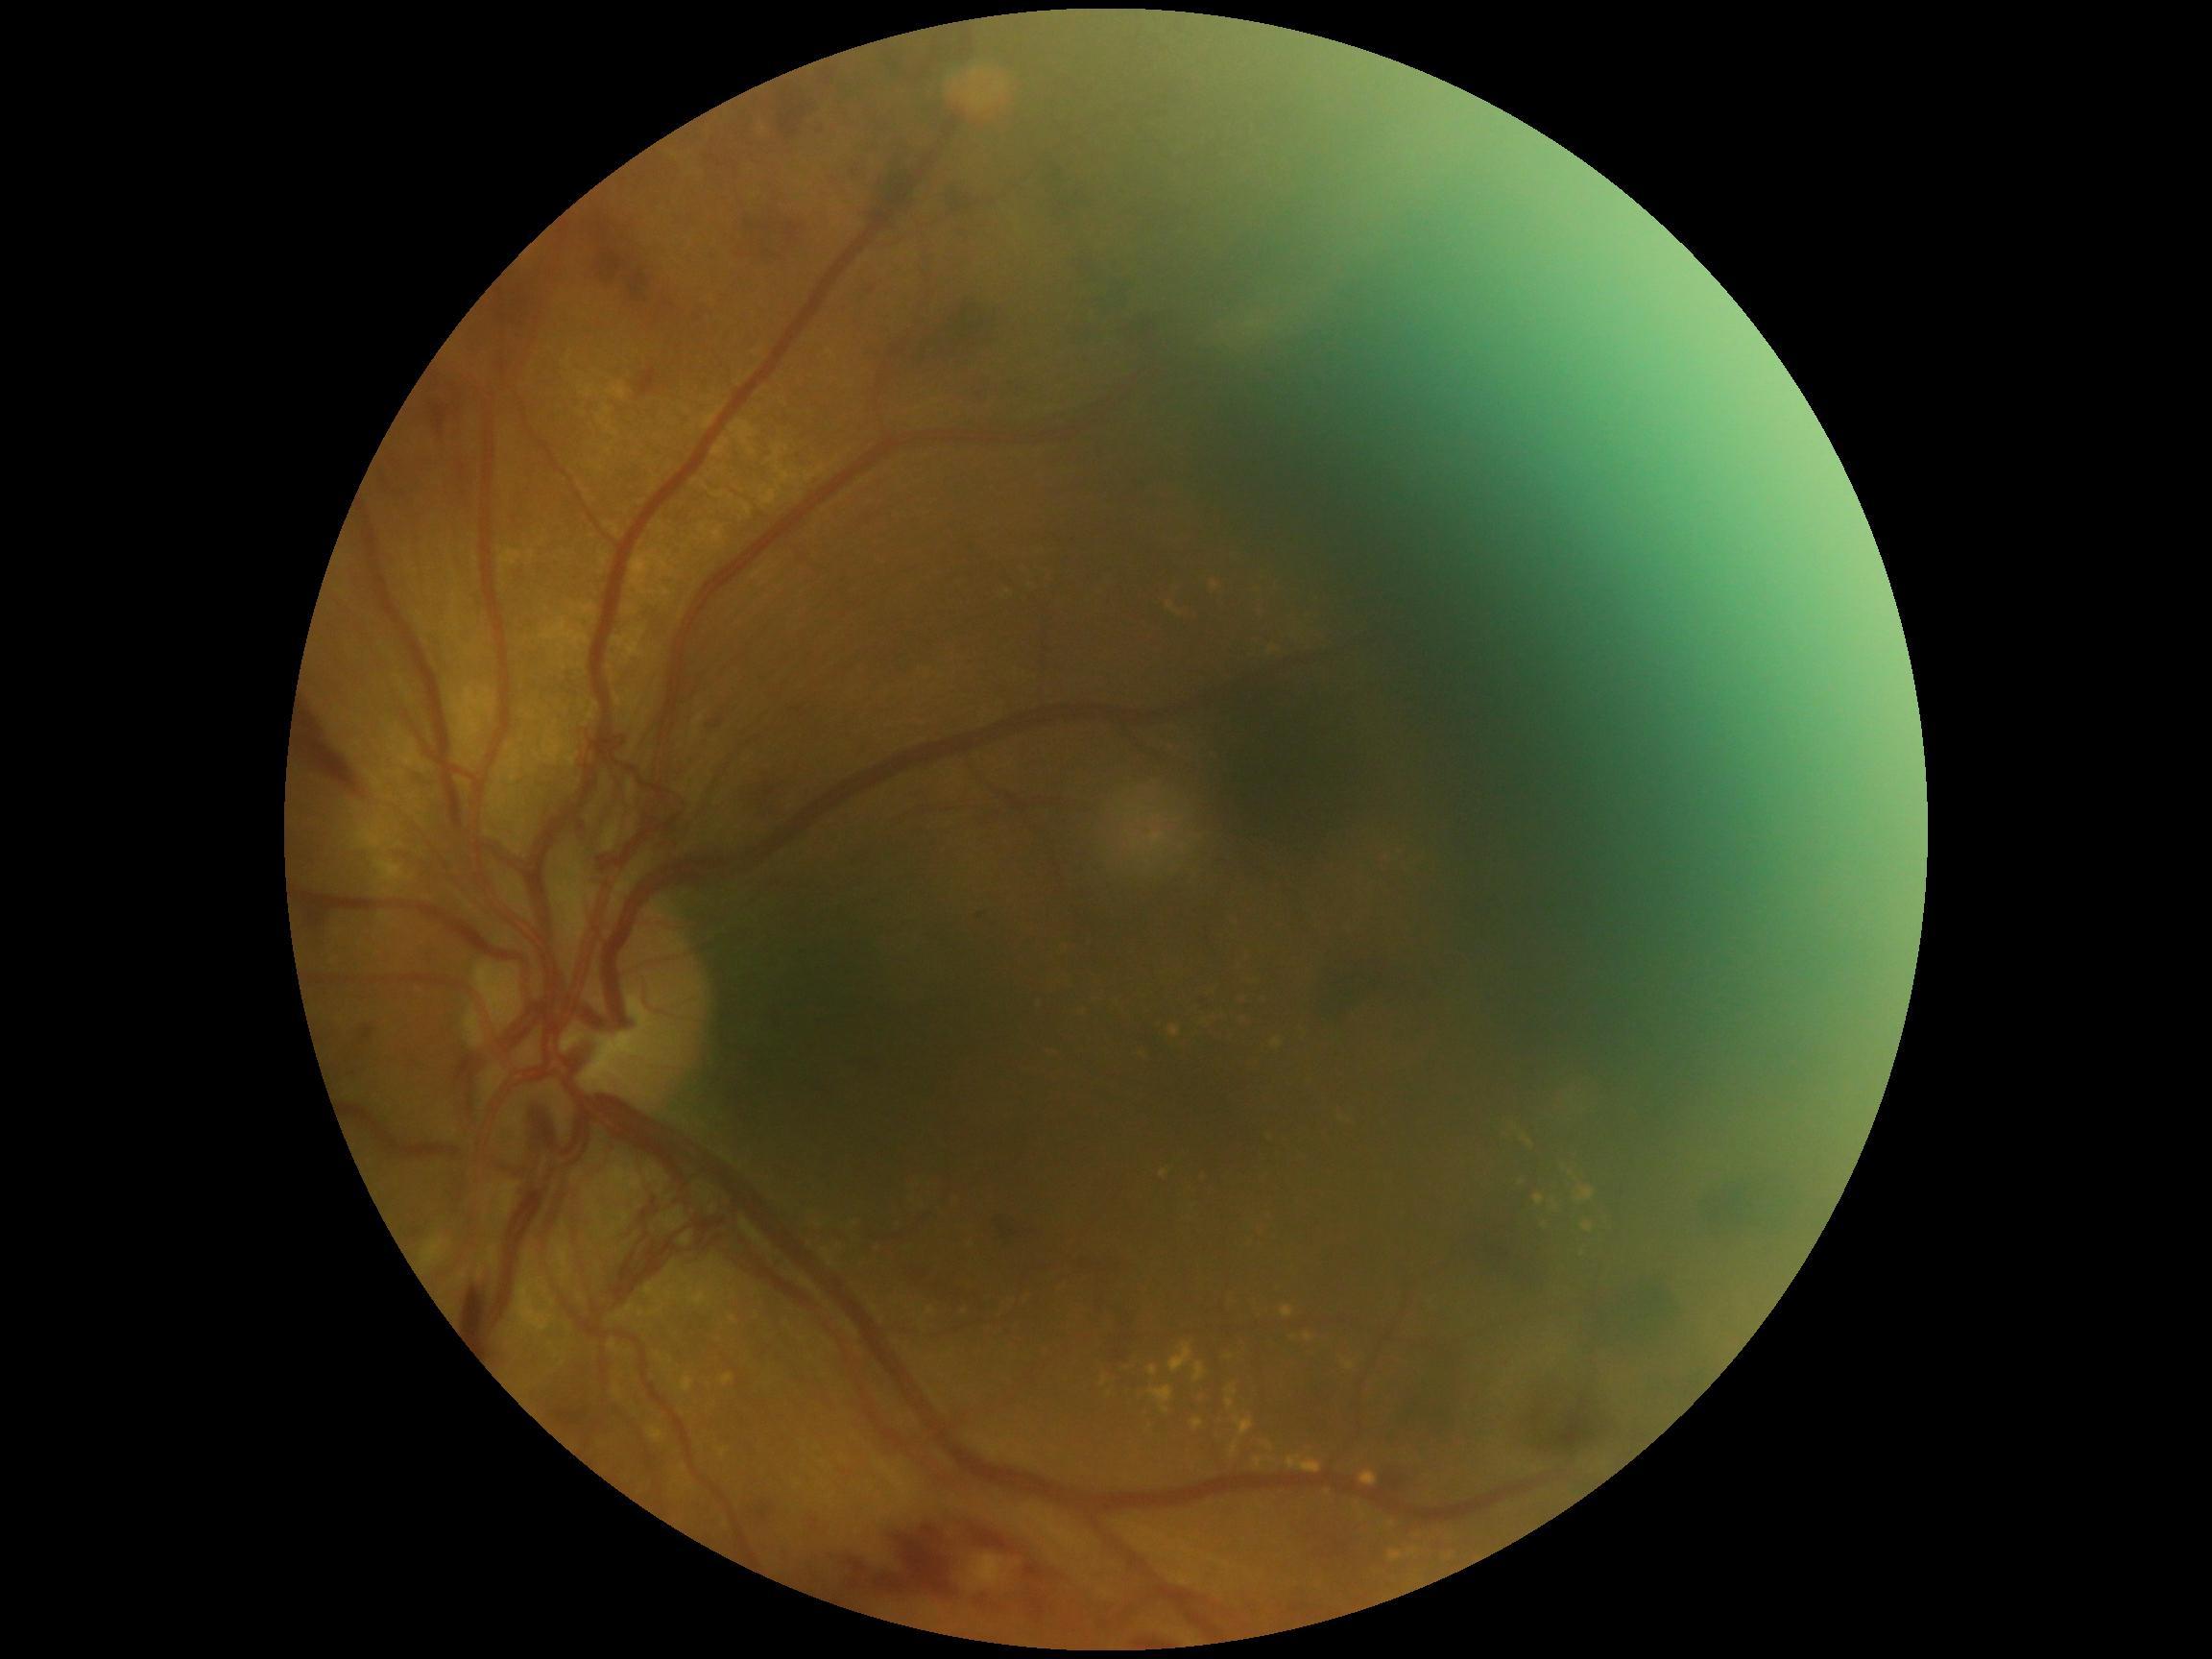
Diabetic retinopathy grade is proliferative diabetic retinopathy (4).